Pediatric wide-field fundus photograph; 640x480 — 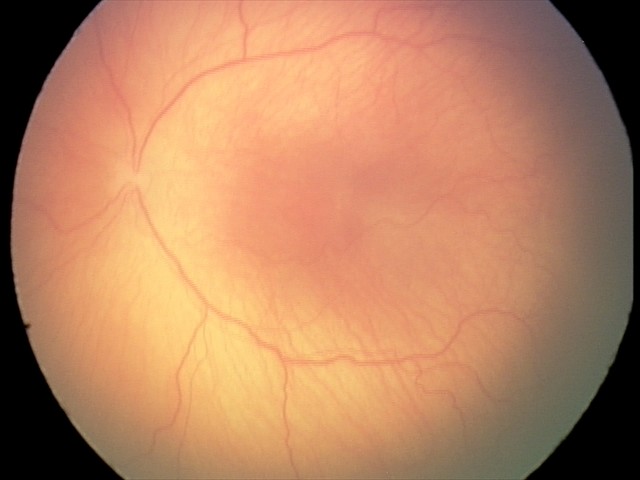
Screening examination consistent with ROP stage 1.